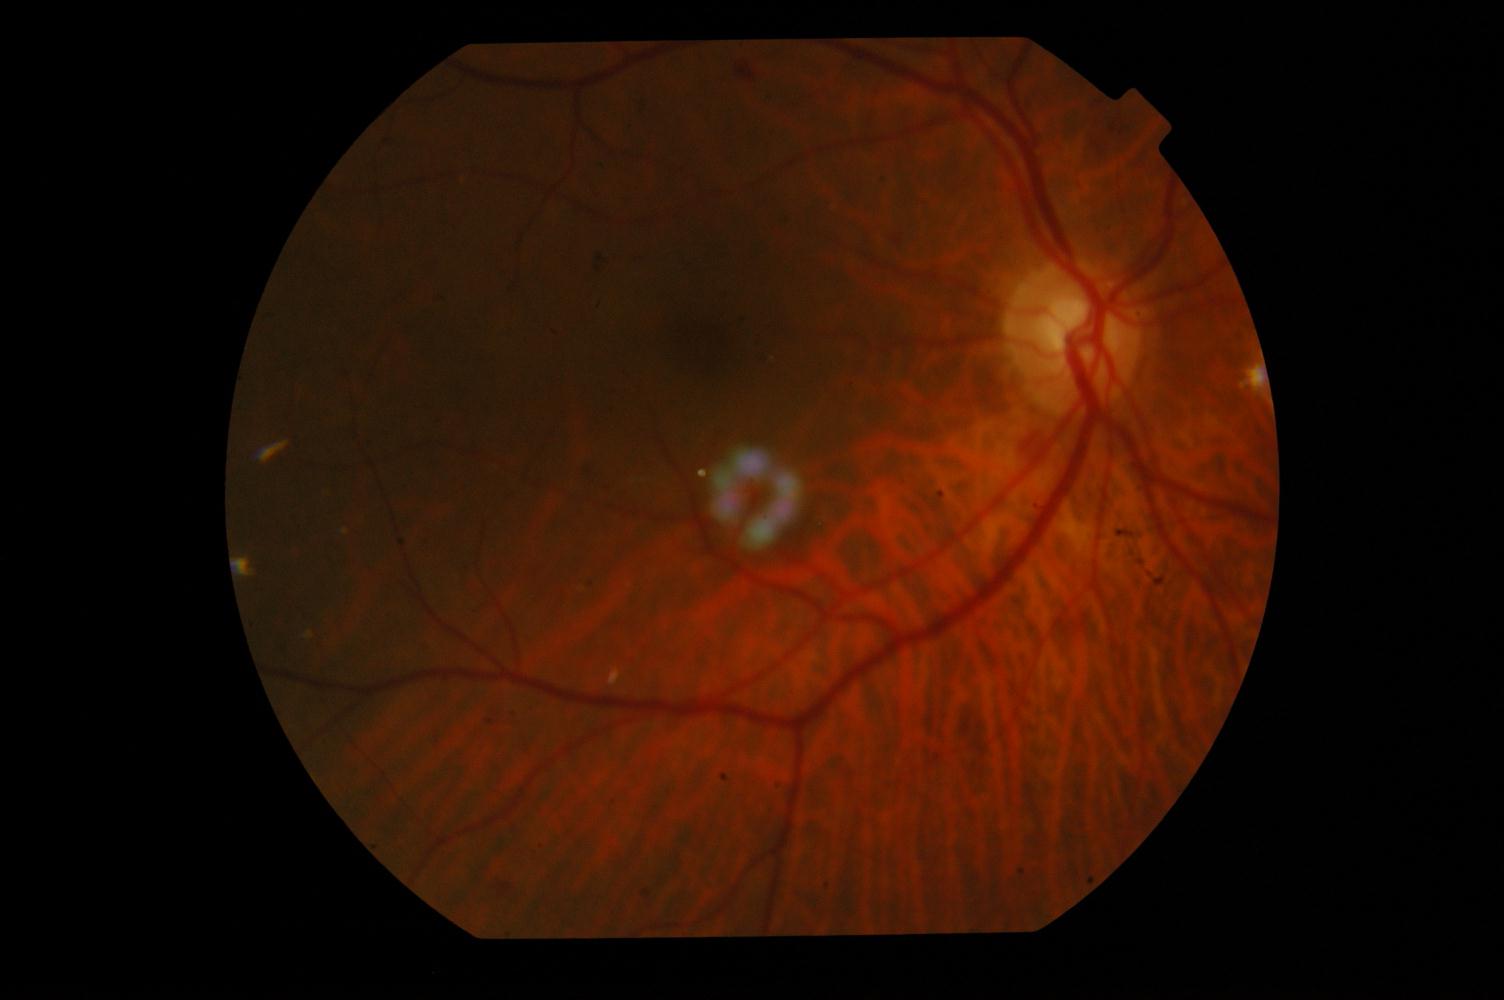

Diagnosis: diabetic retinopathy (DR).